Davis DR grading:
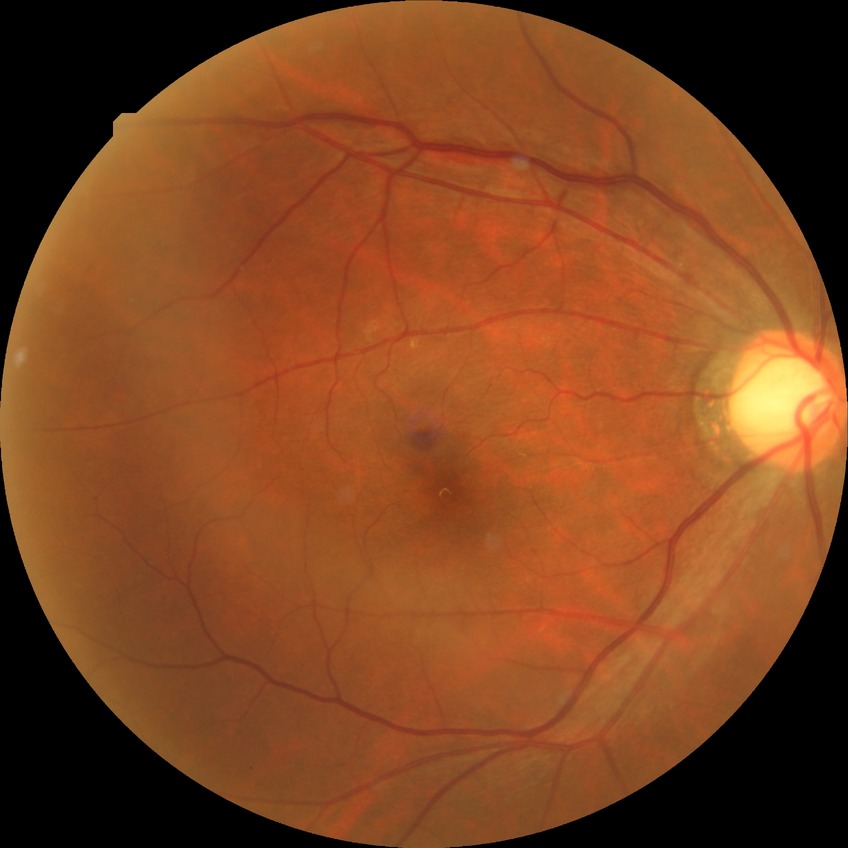 {
  "davis_grade": "SDR (simple diabetic retinopathy)"
}